1932 by 1910 pixels; color fundus photograph; 45-degree field of view — 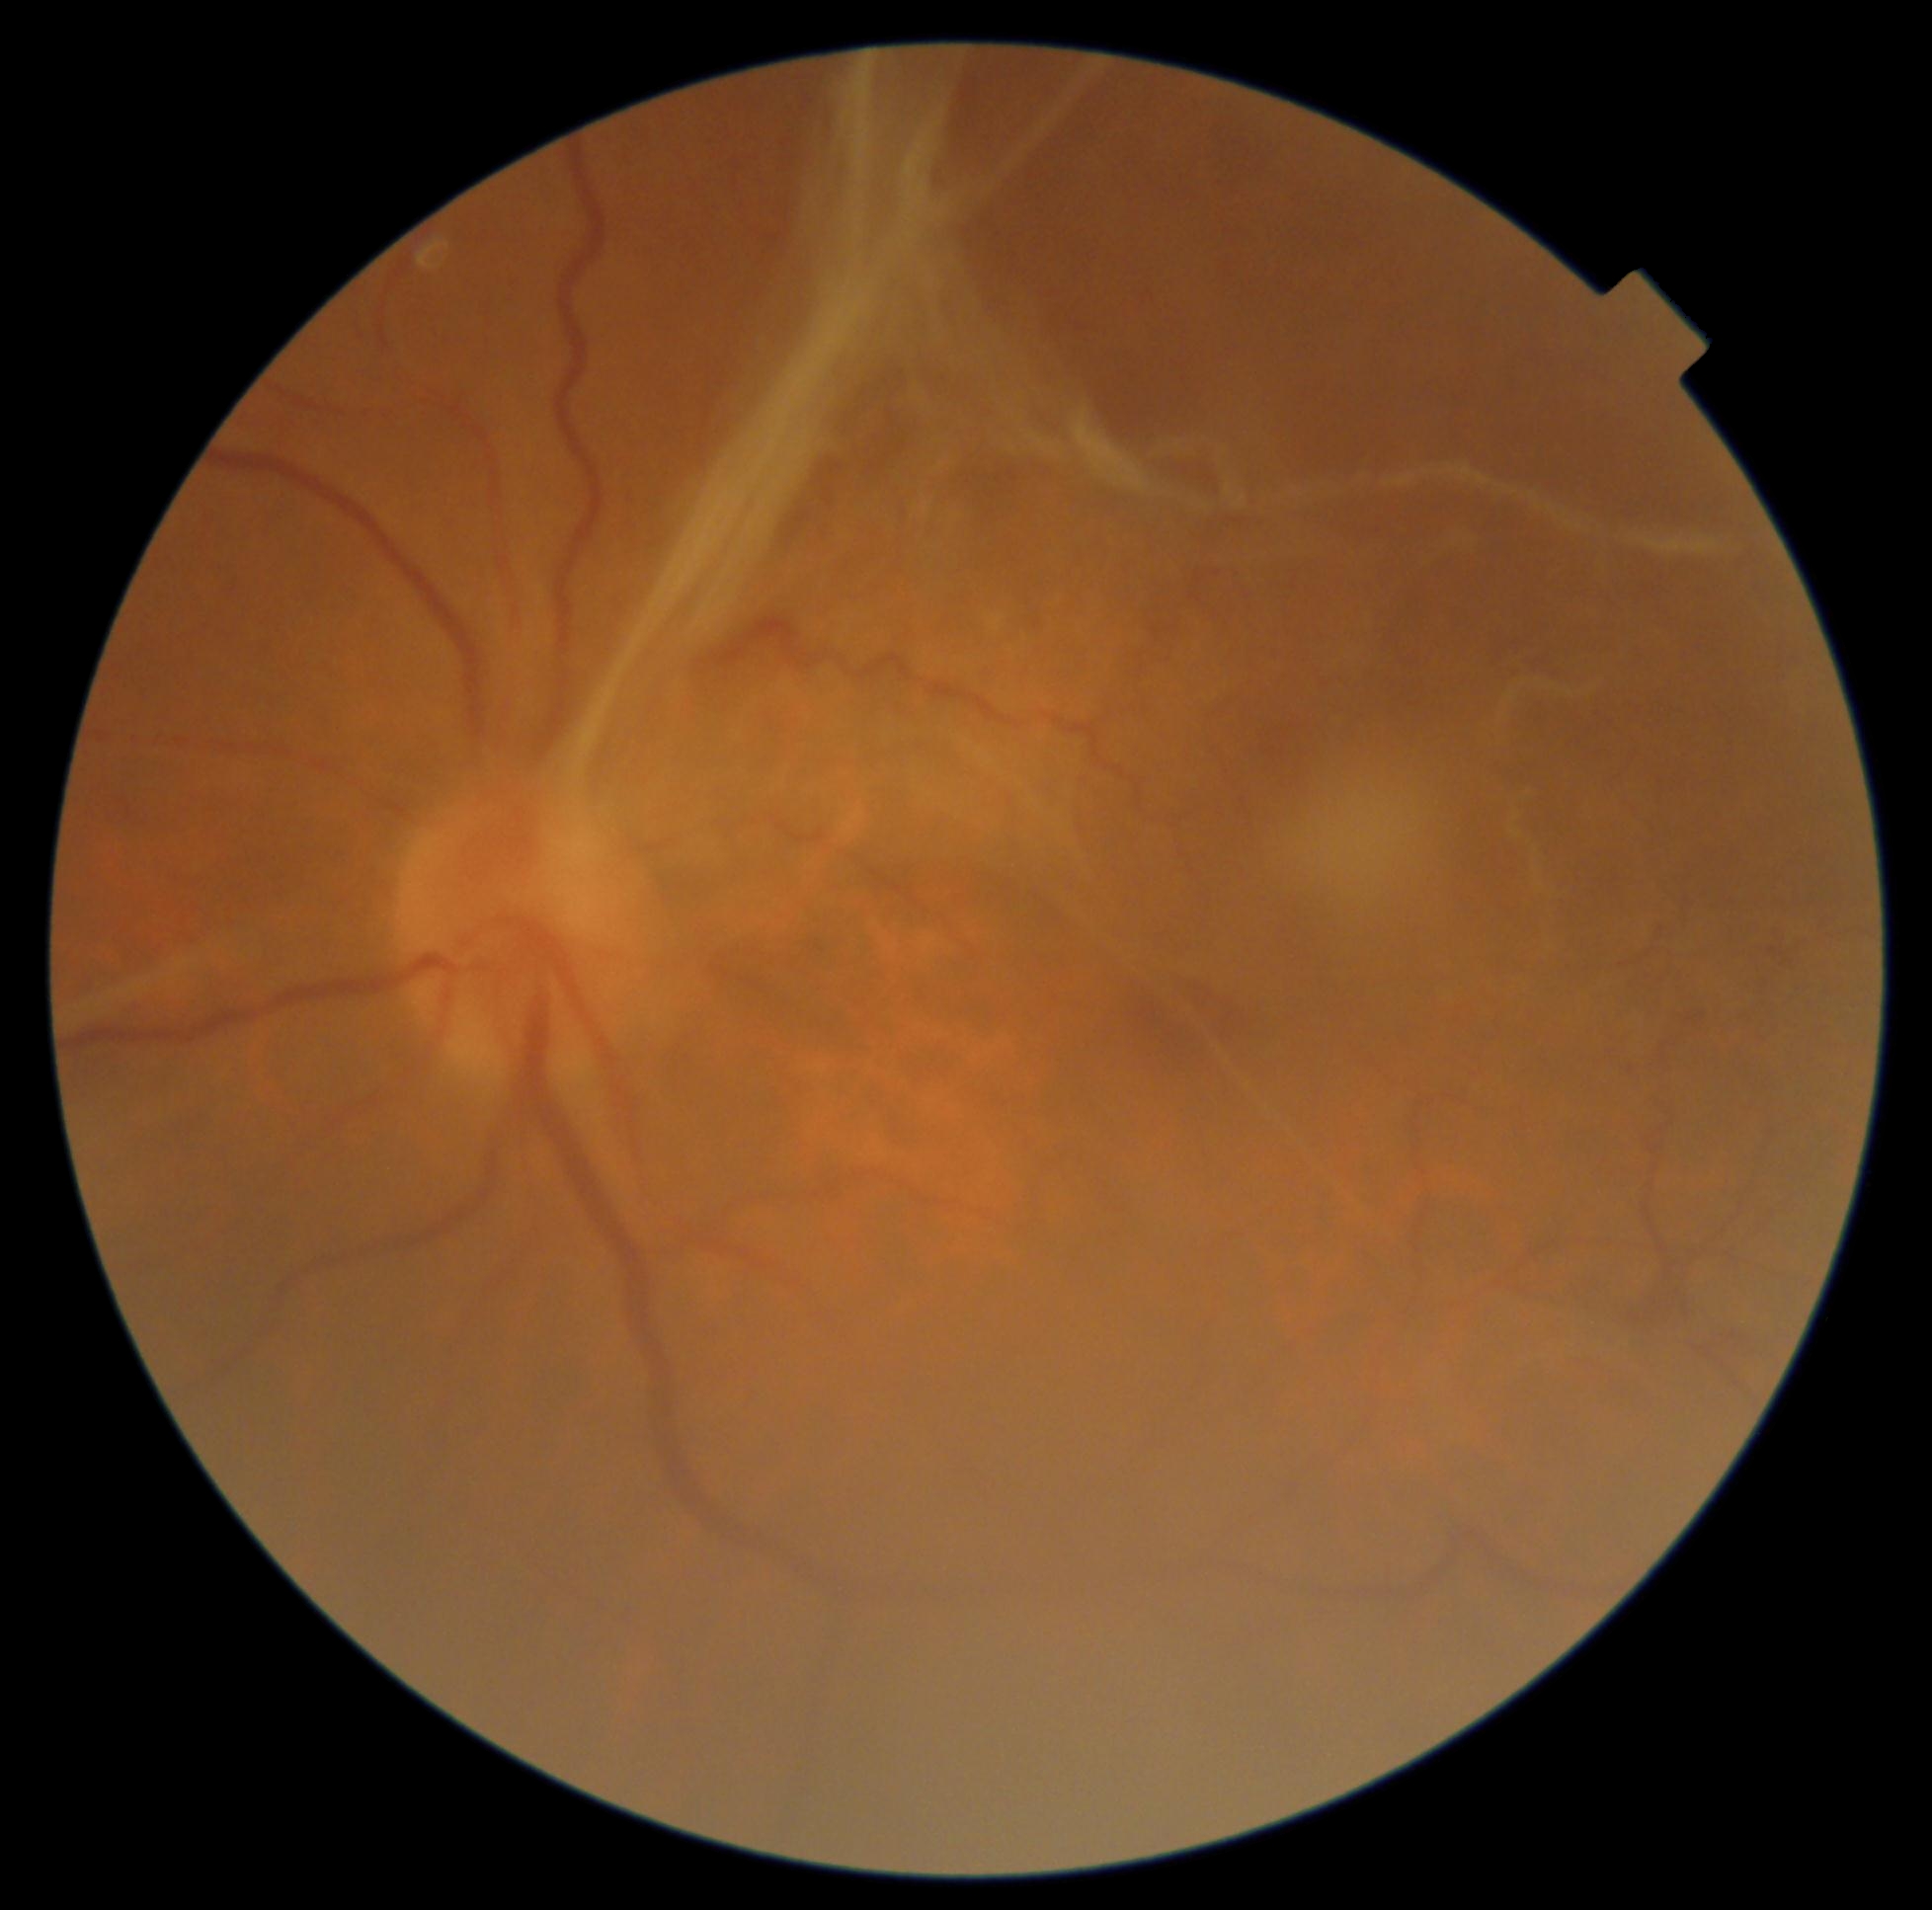
Annotations:
• DR stage — 4